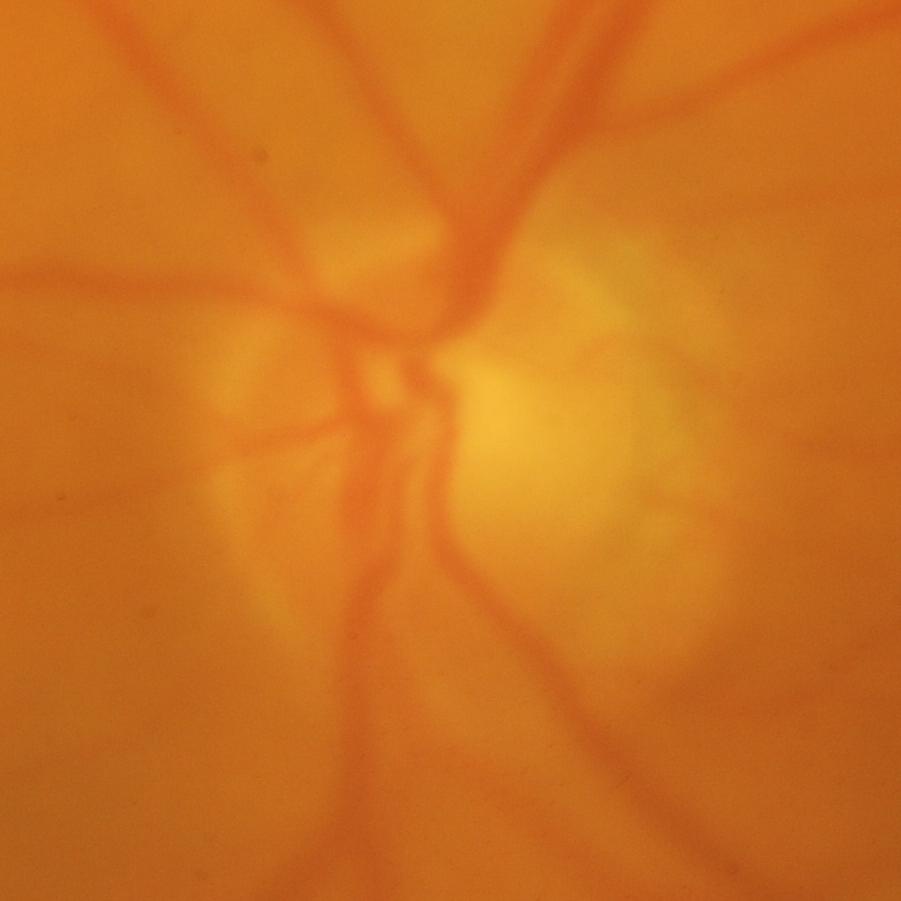

Optic nerve head photograph demonstrating glaucomatous optic neuropathy.